45° FOV:
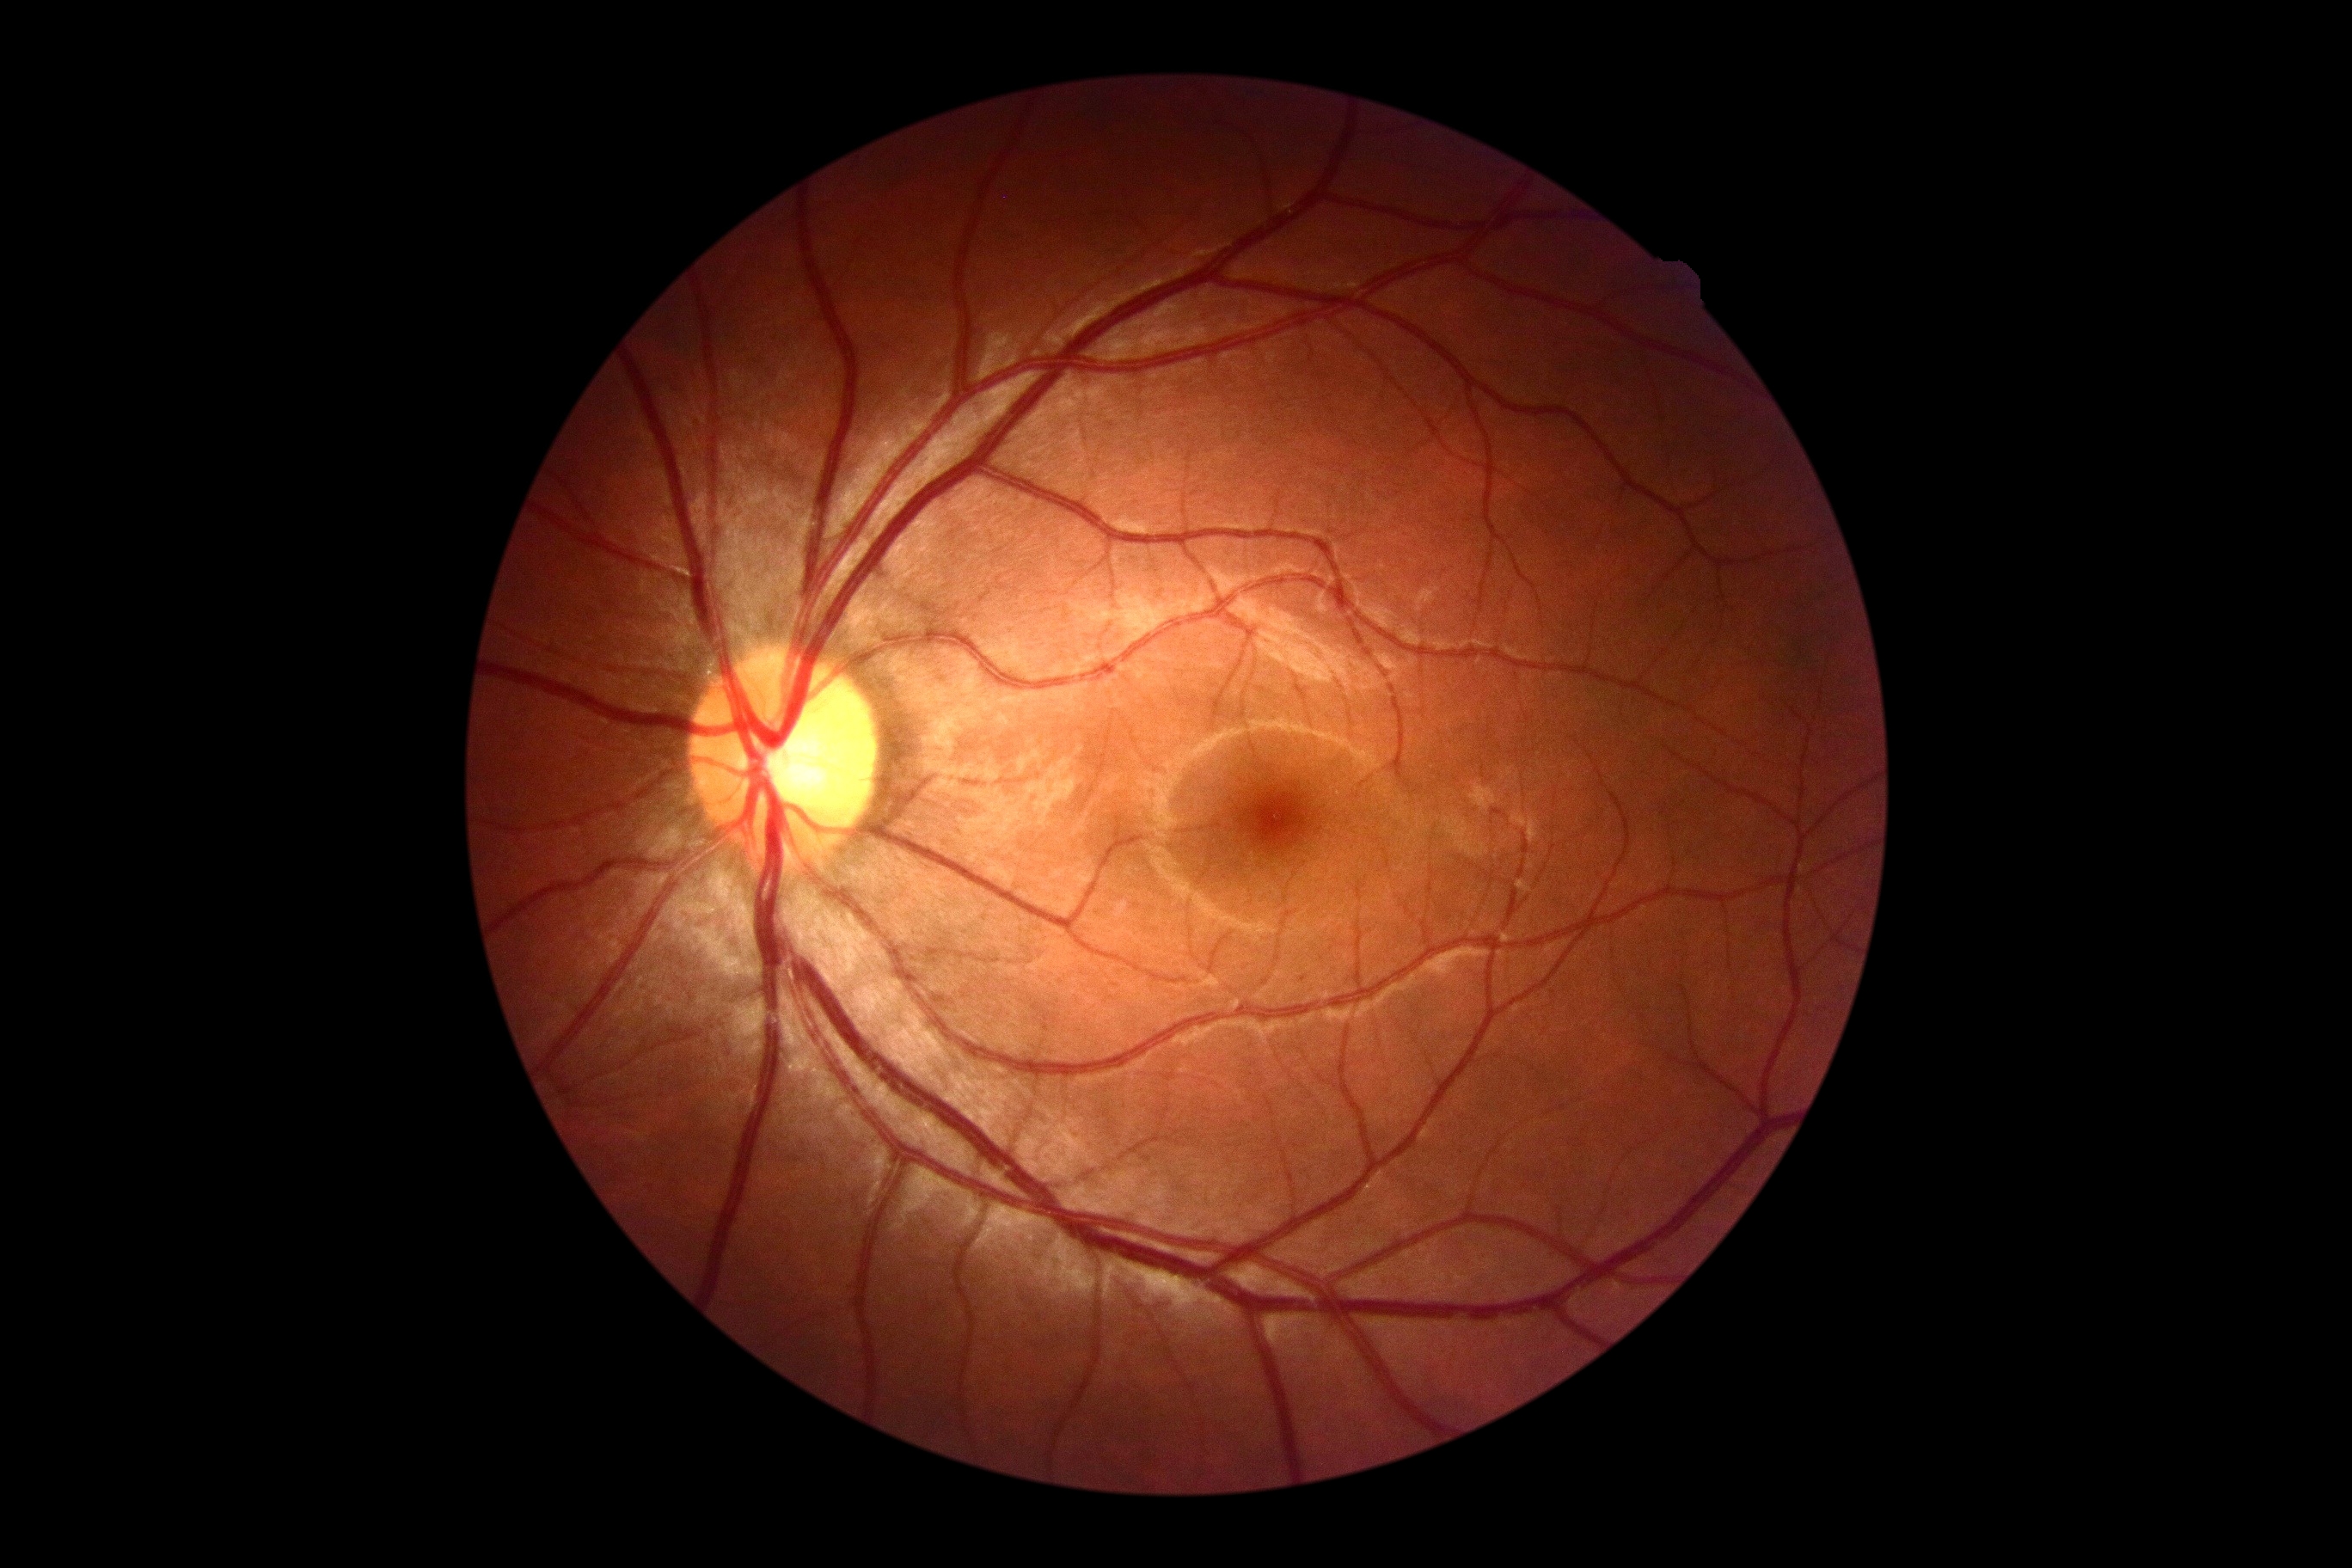
- DR impression: no signs of DR
- retinopathy grade: 0